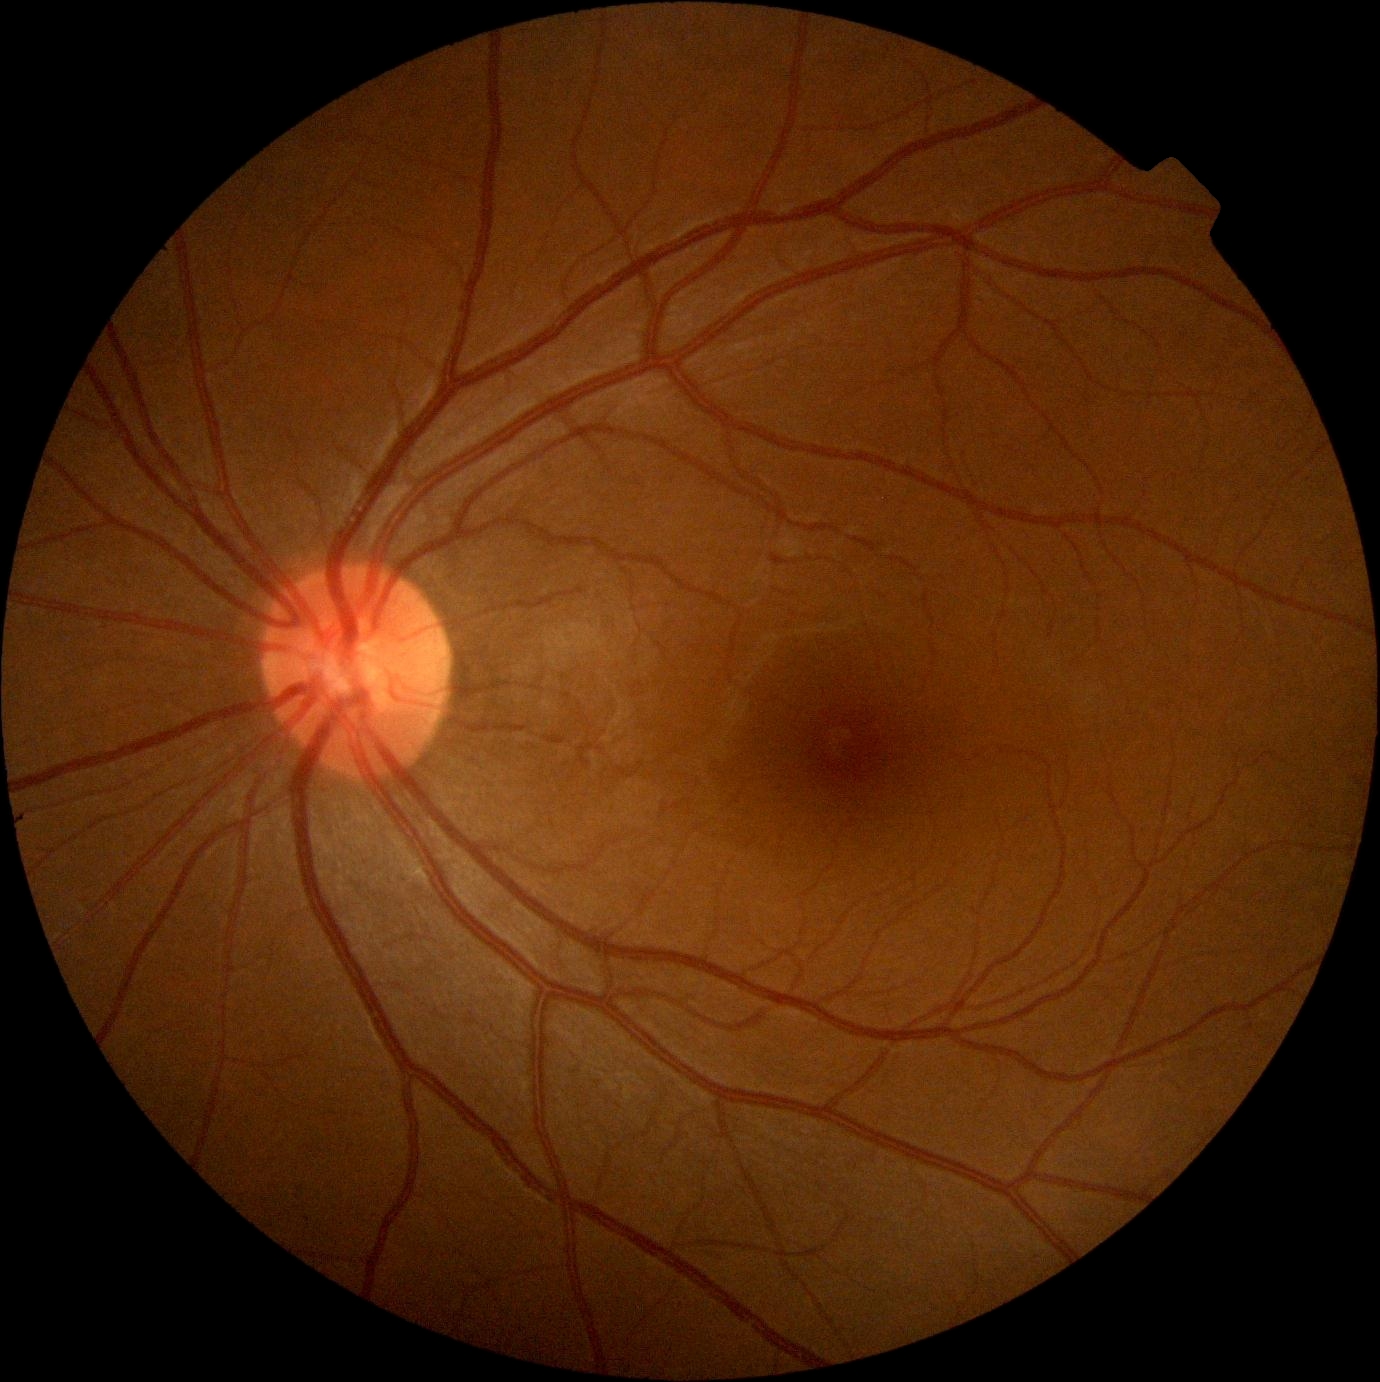 No diabetic retinal disease findings. Retinopathy grade: no apparent retinopathy (0).